CFP · 1659x2212 · captured on a Remidio Fundus on Phone (FOP) camera
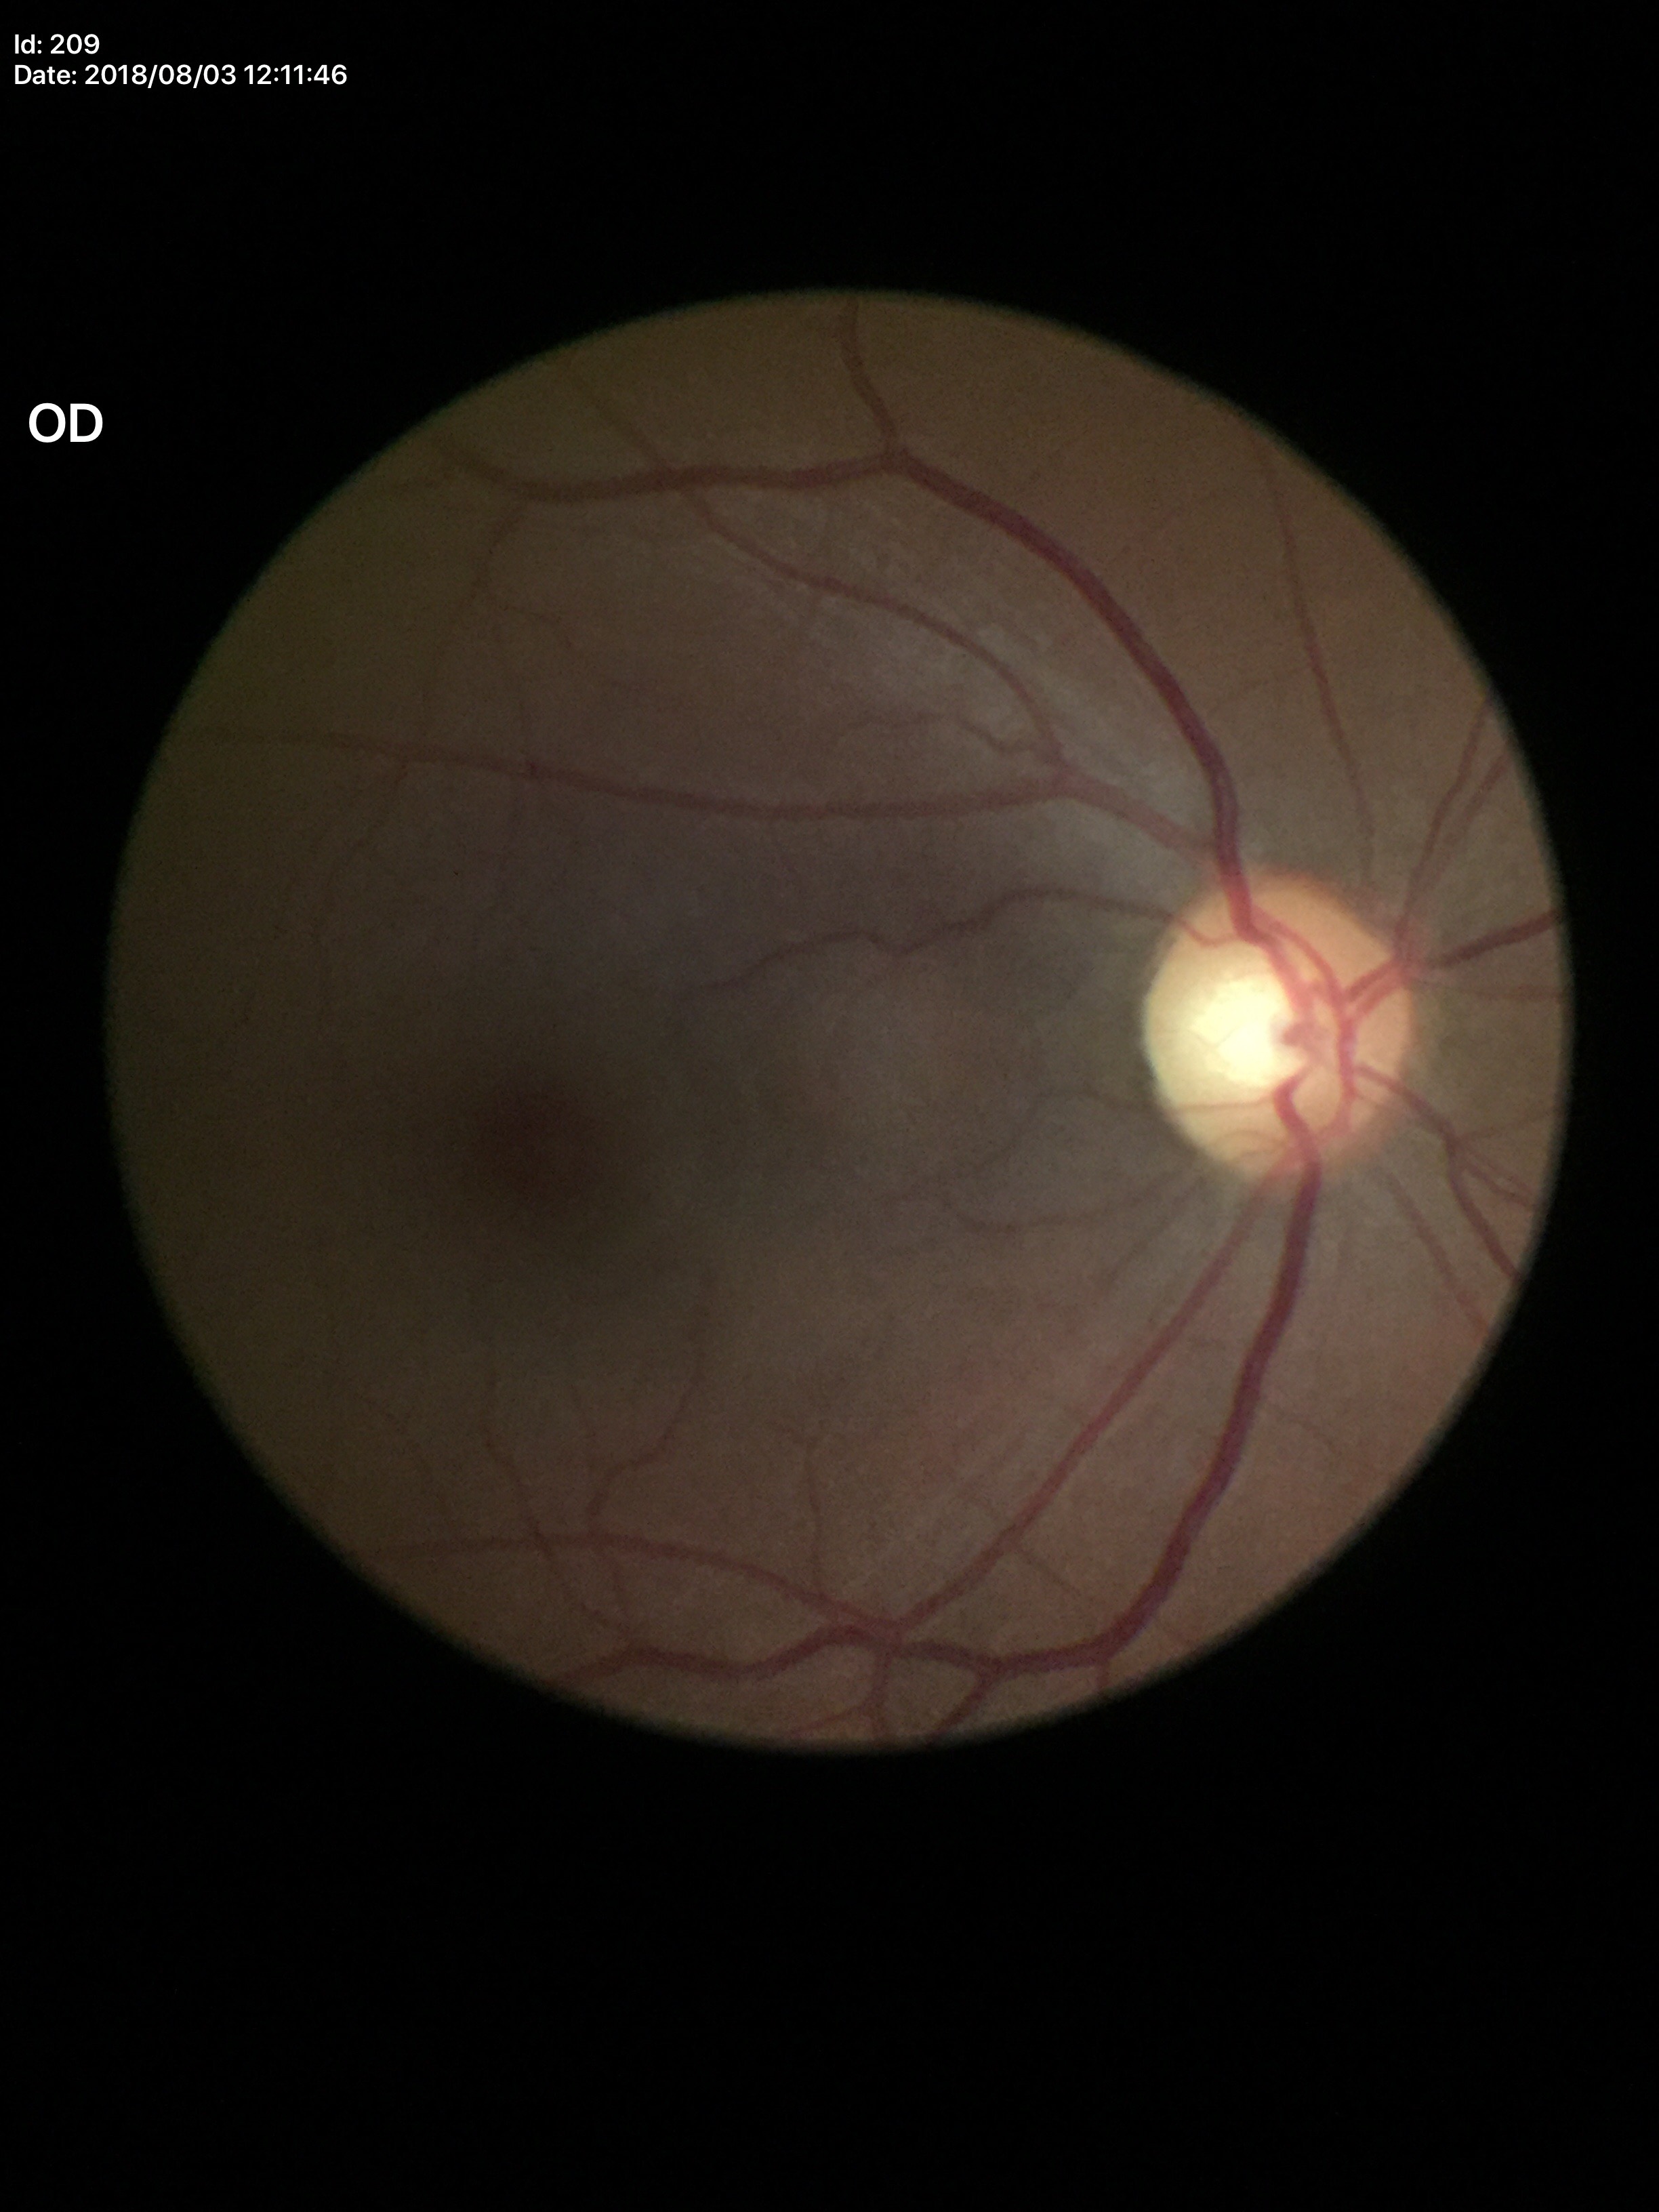 Glaucoma screening impression: negative. Vertical C/D ratio (VCDR) of 0.50.